Pediatric retinal photograph (wide-field).
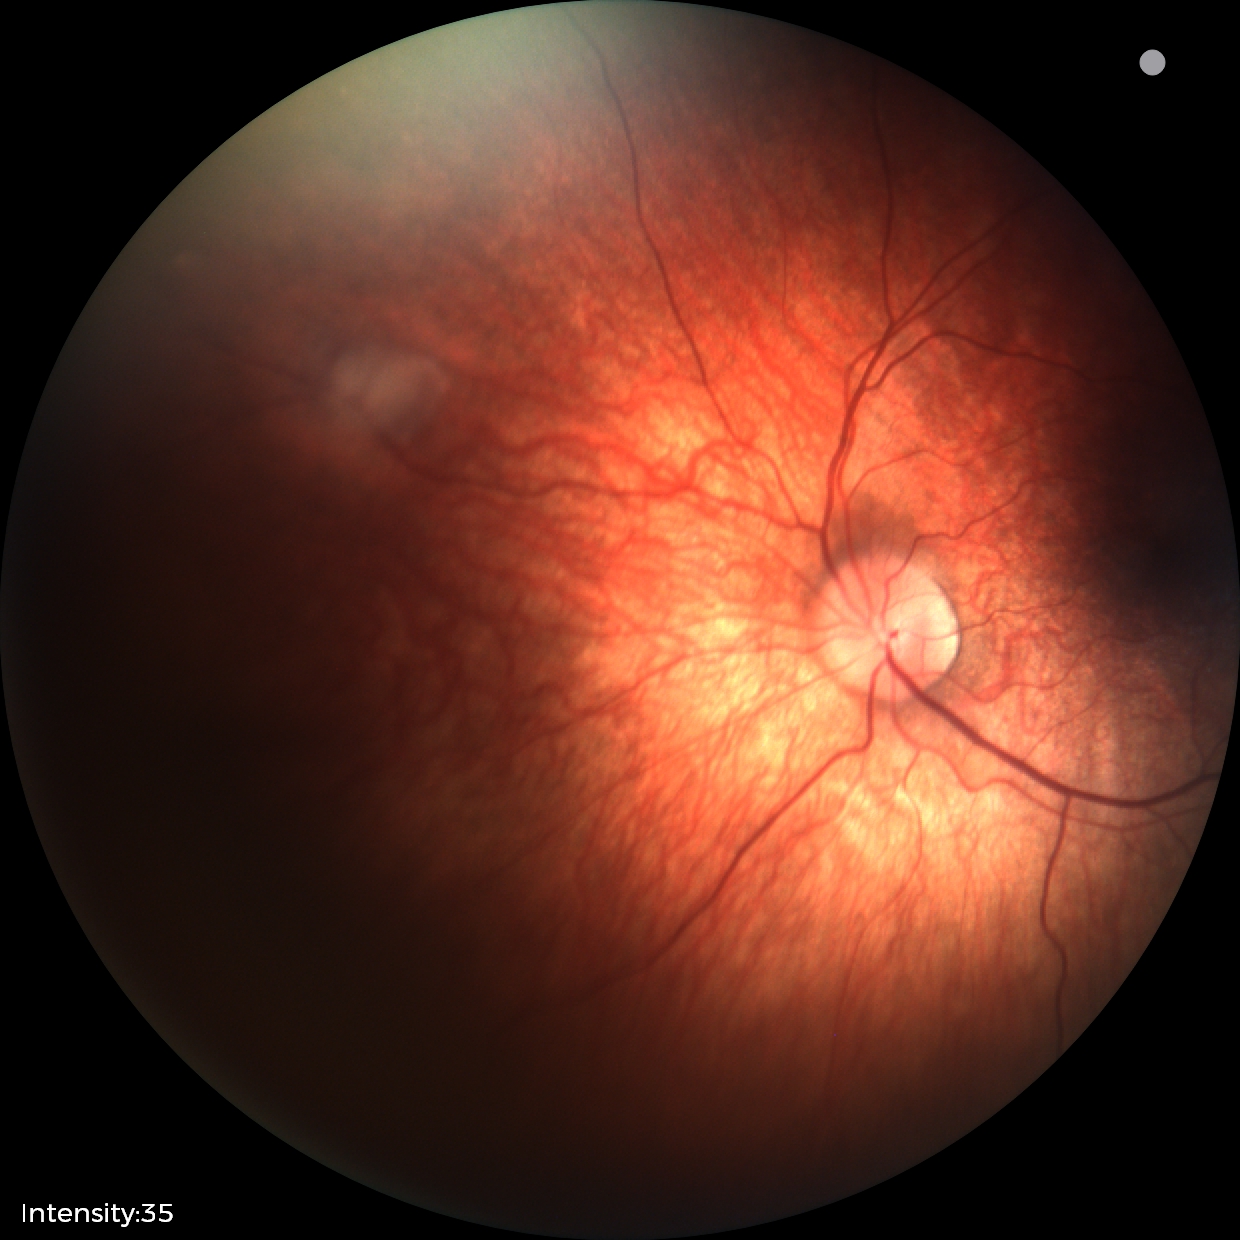 From an examination with diagnosis of retinal astrocytic hamartoma.